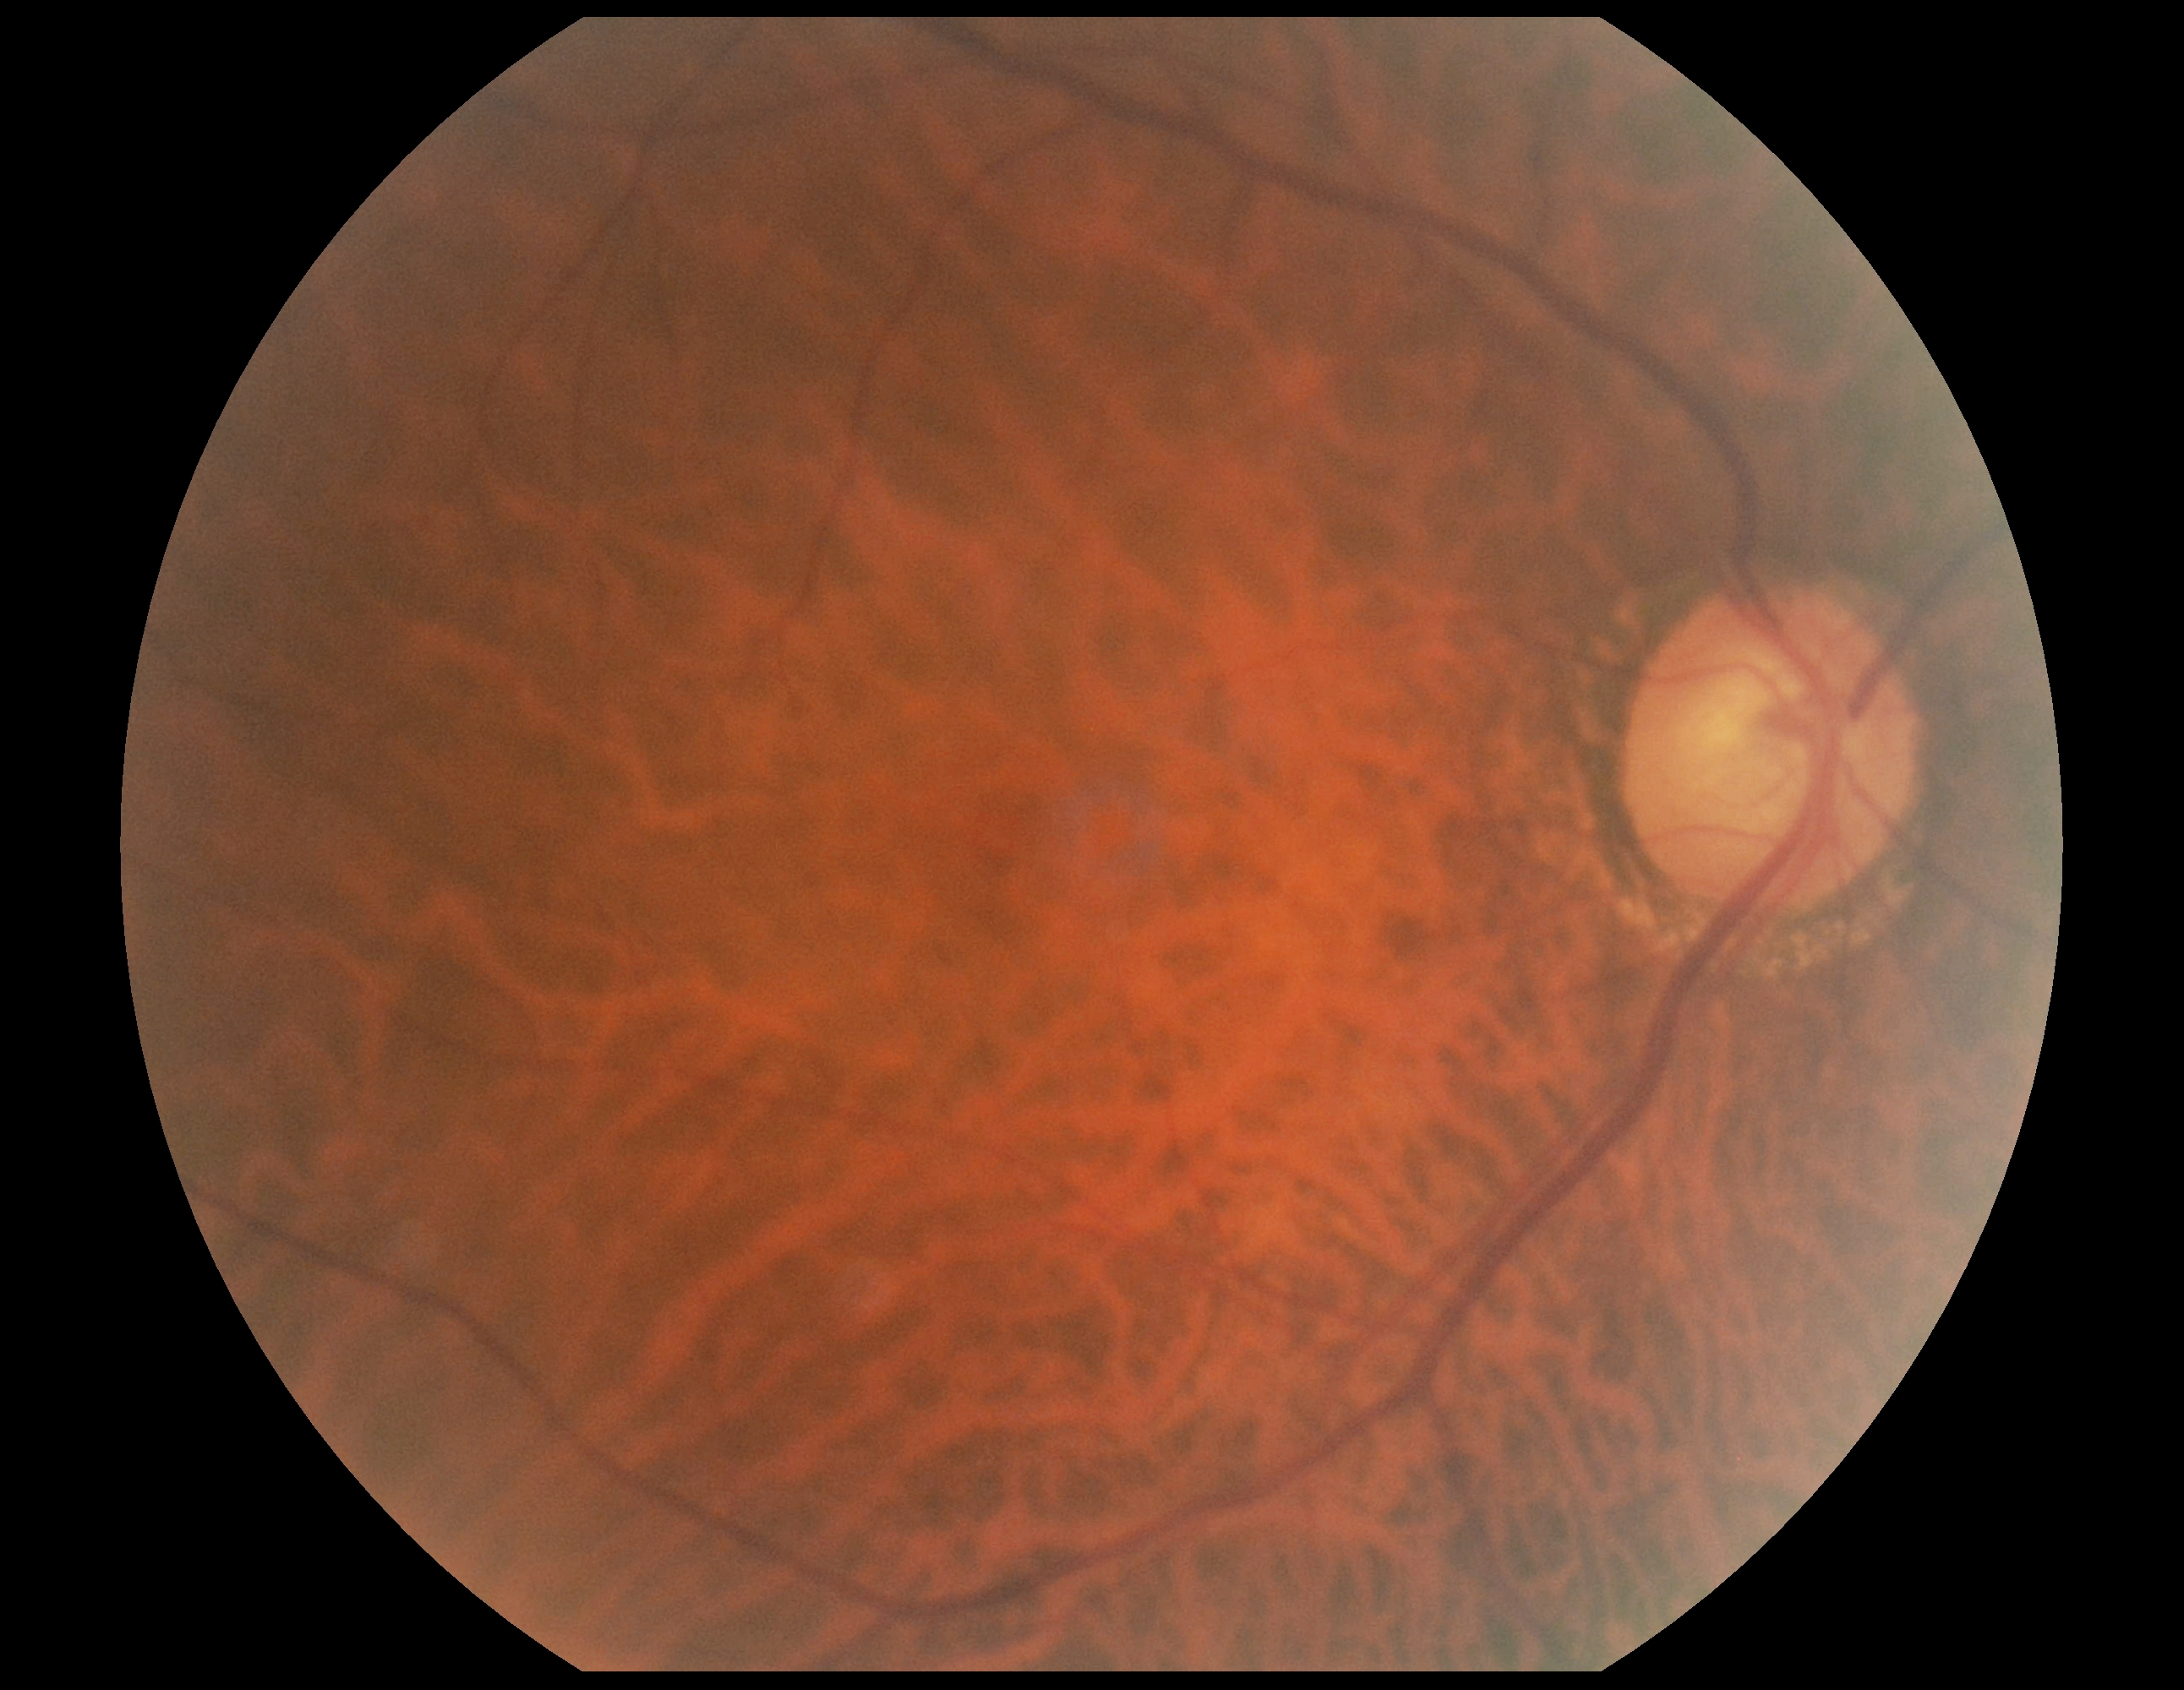

Diabetic retinopathy: 0/4. No apparent diabetic retinopathy.